Fundus photo.
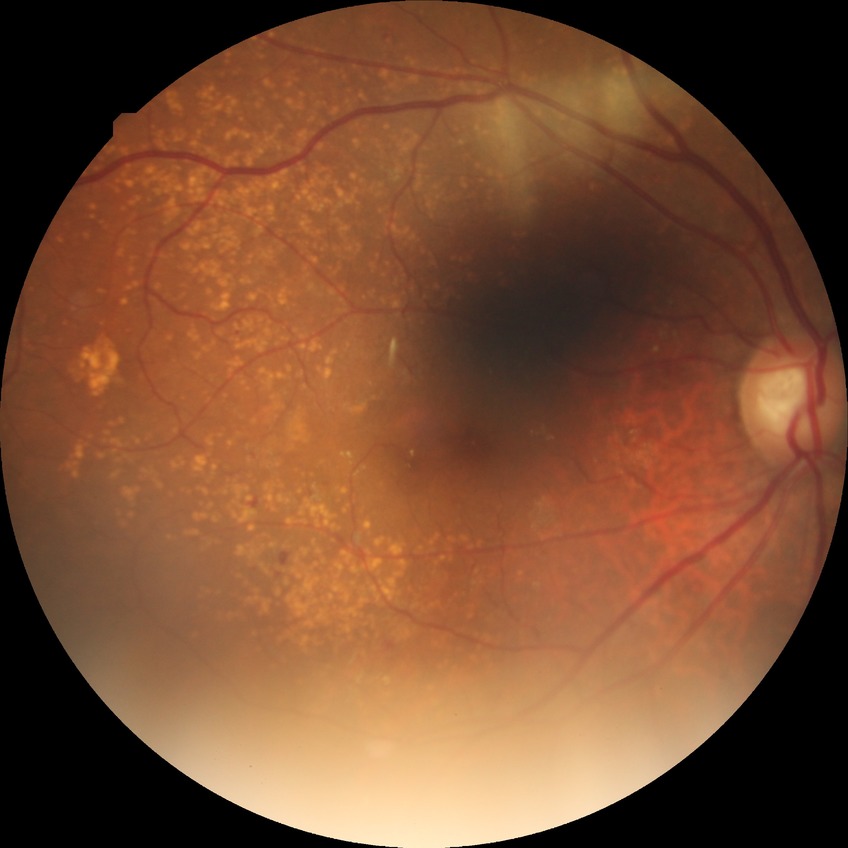
modified Davis grading@simple diabetic retinopathy.